45 degree fundus photograph. Nonmydriatic fundus photograph. 848 by 848 pixels. DR severity per modified Davis staging.
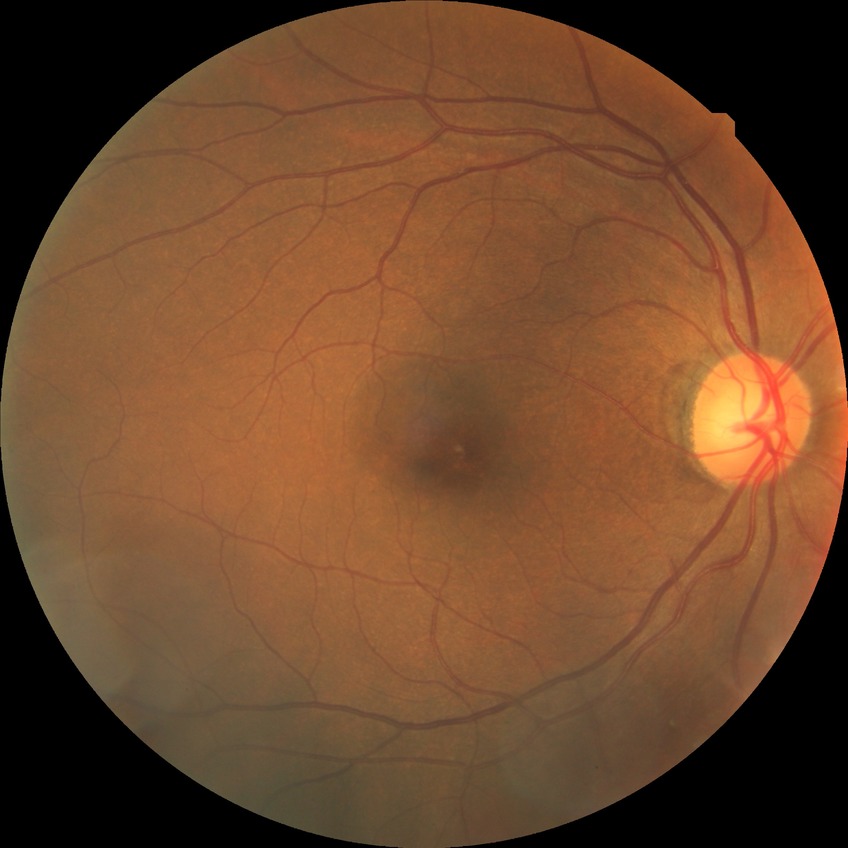
diabetic retinopathy (DR): no diabetic retinopathy (NDR).